Captured with the Phoenix ICON (100° field of view). Infant wide-field retinal image.
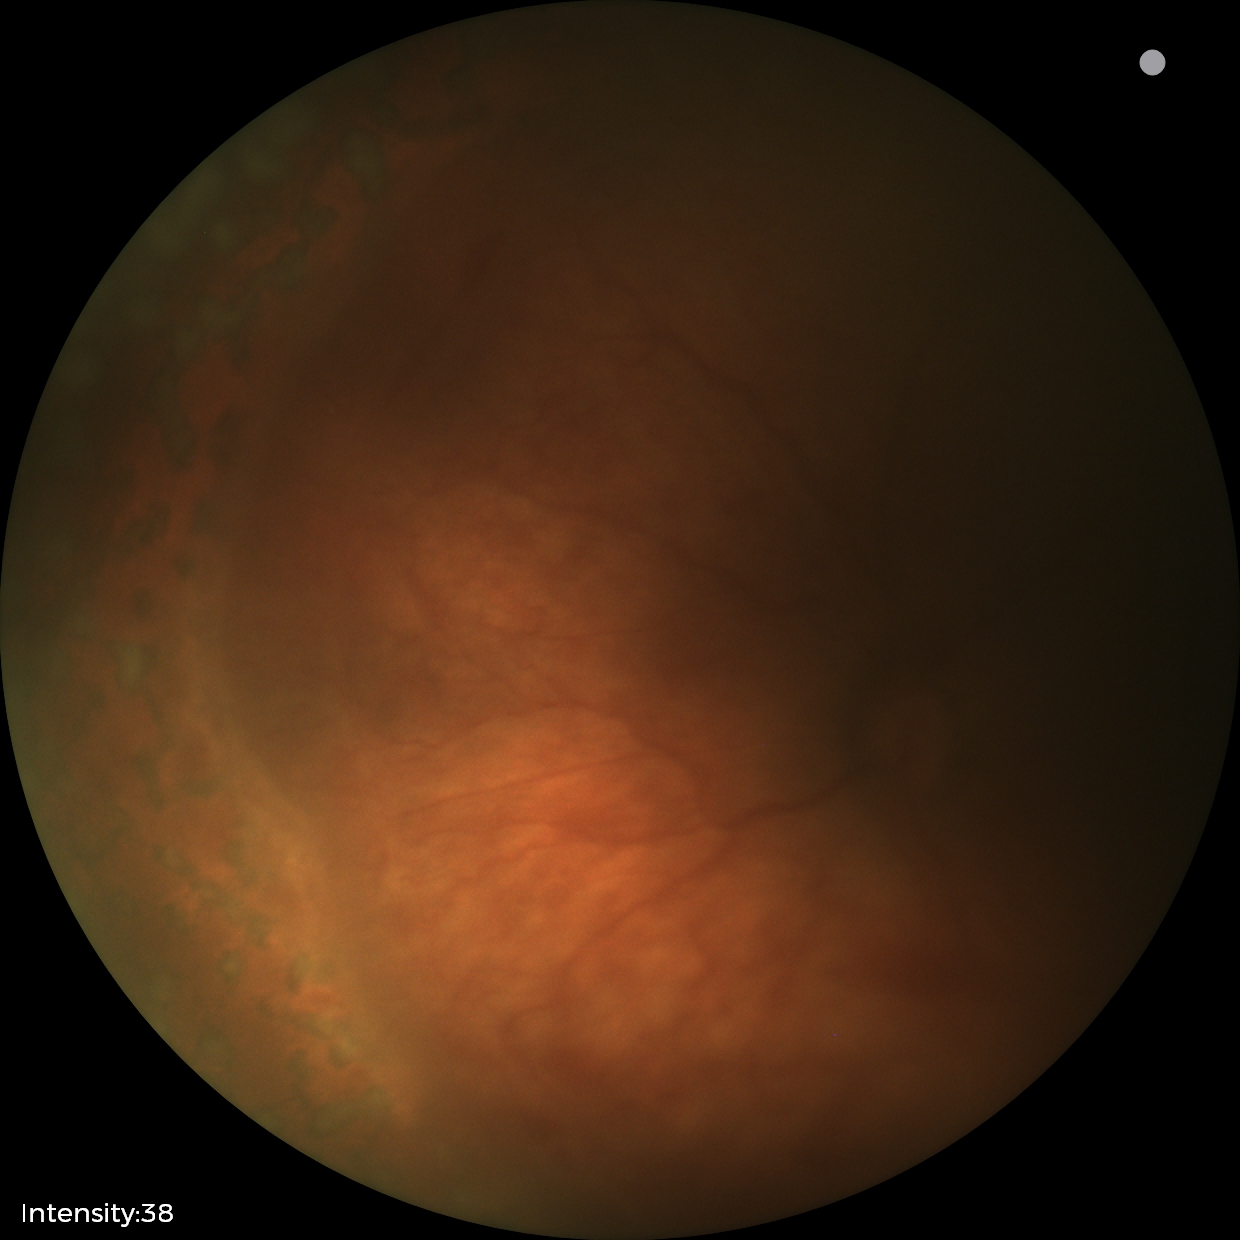

No plus disease.
Screening series with status post ROP.